Acquired on the Natus RetCam Envision · infant wide-field fundus photograph.
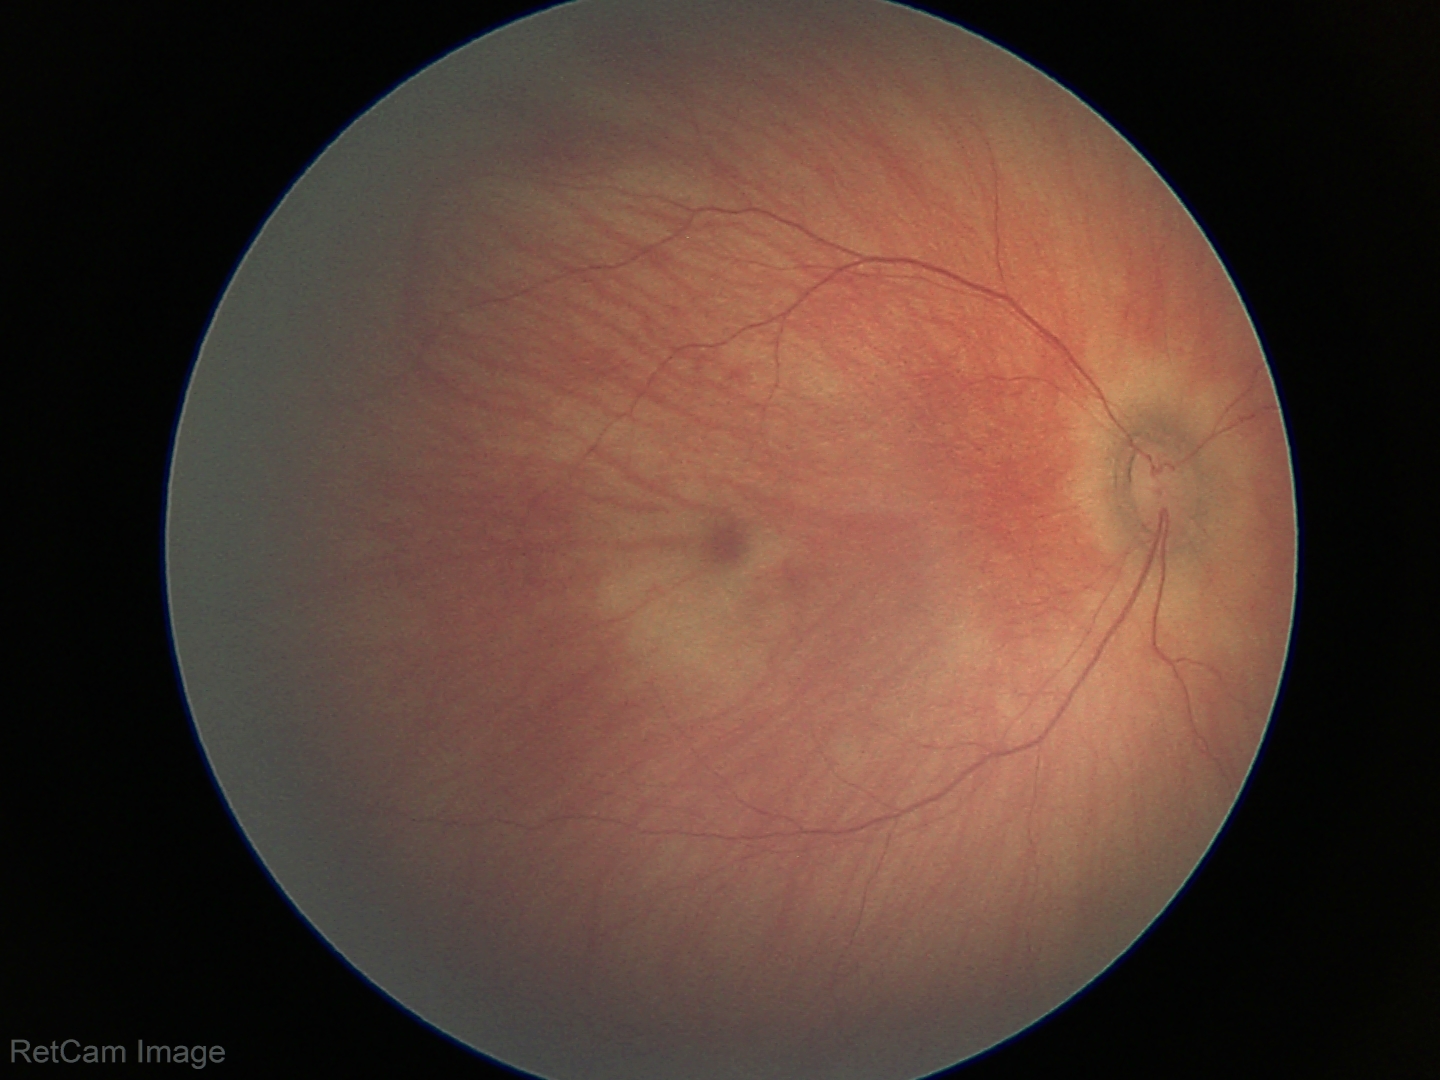

Screening examination diagnosed as physiological.